Portable fundus camera image.
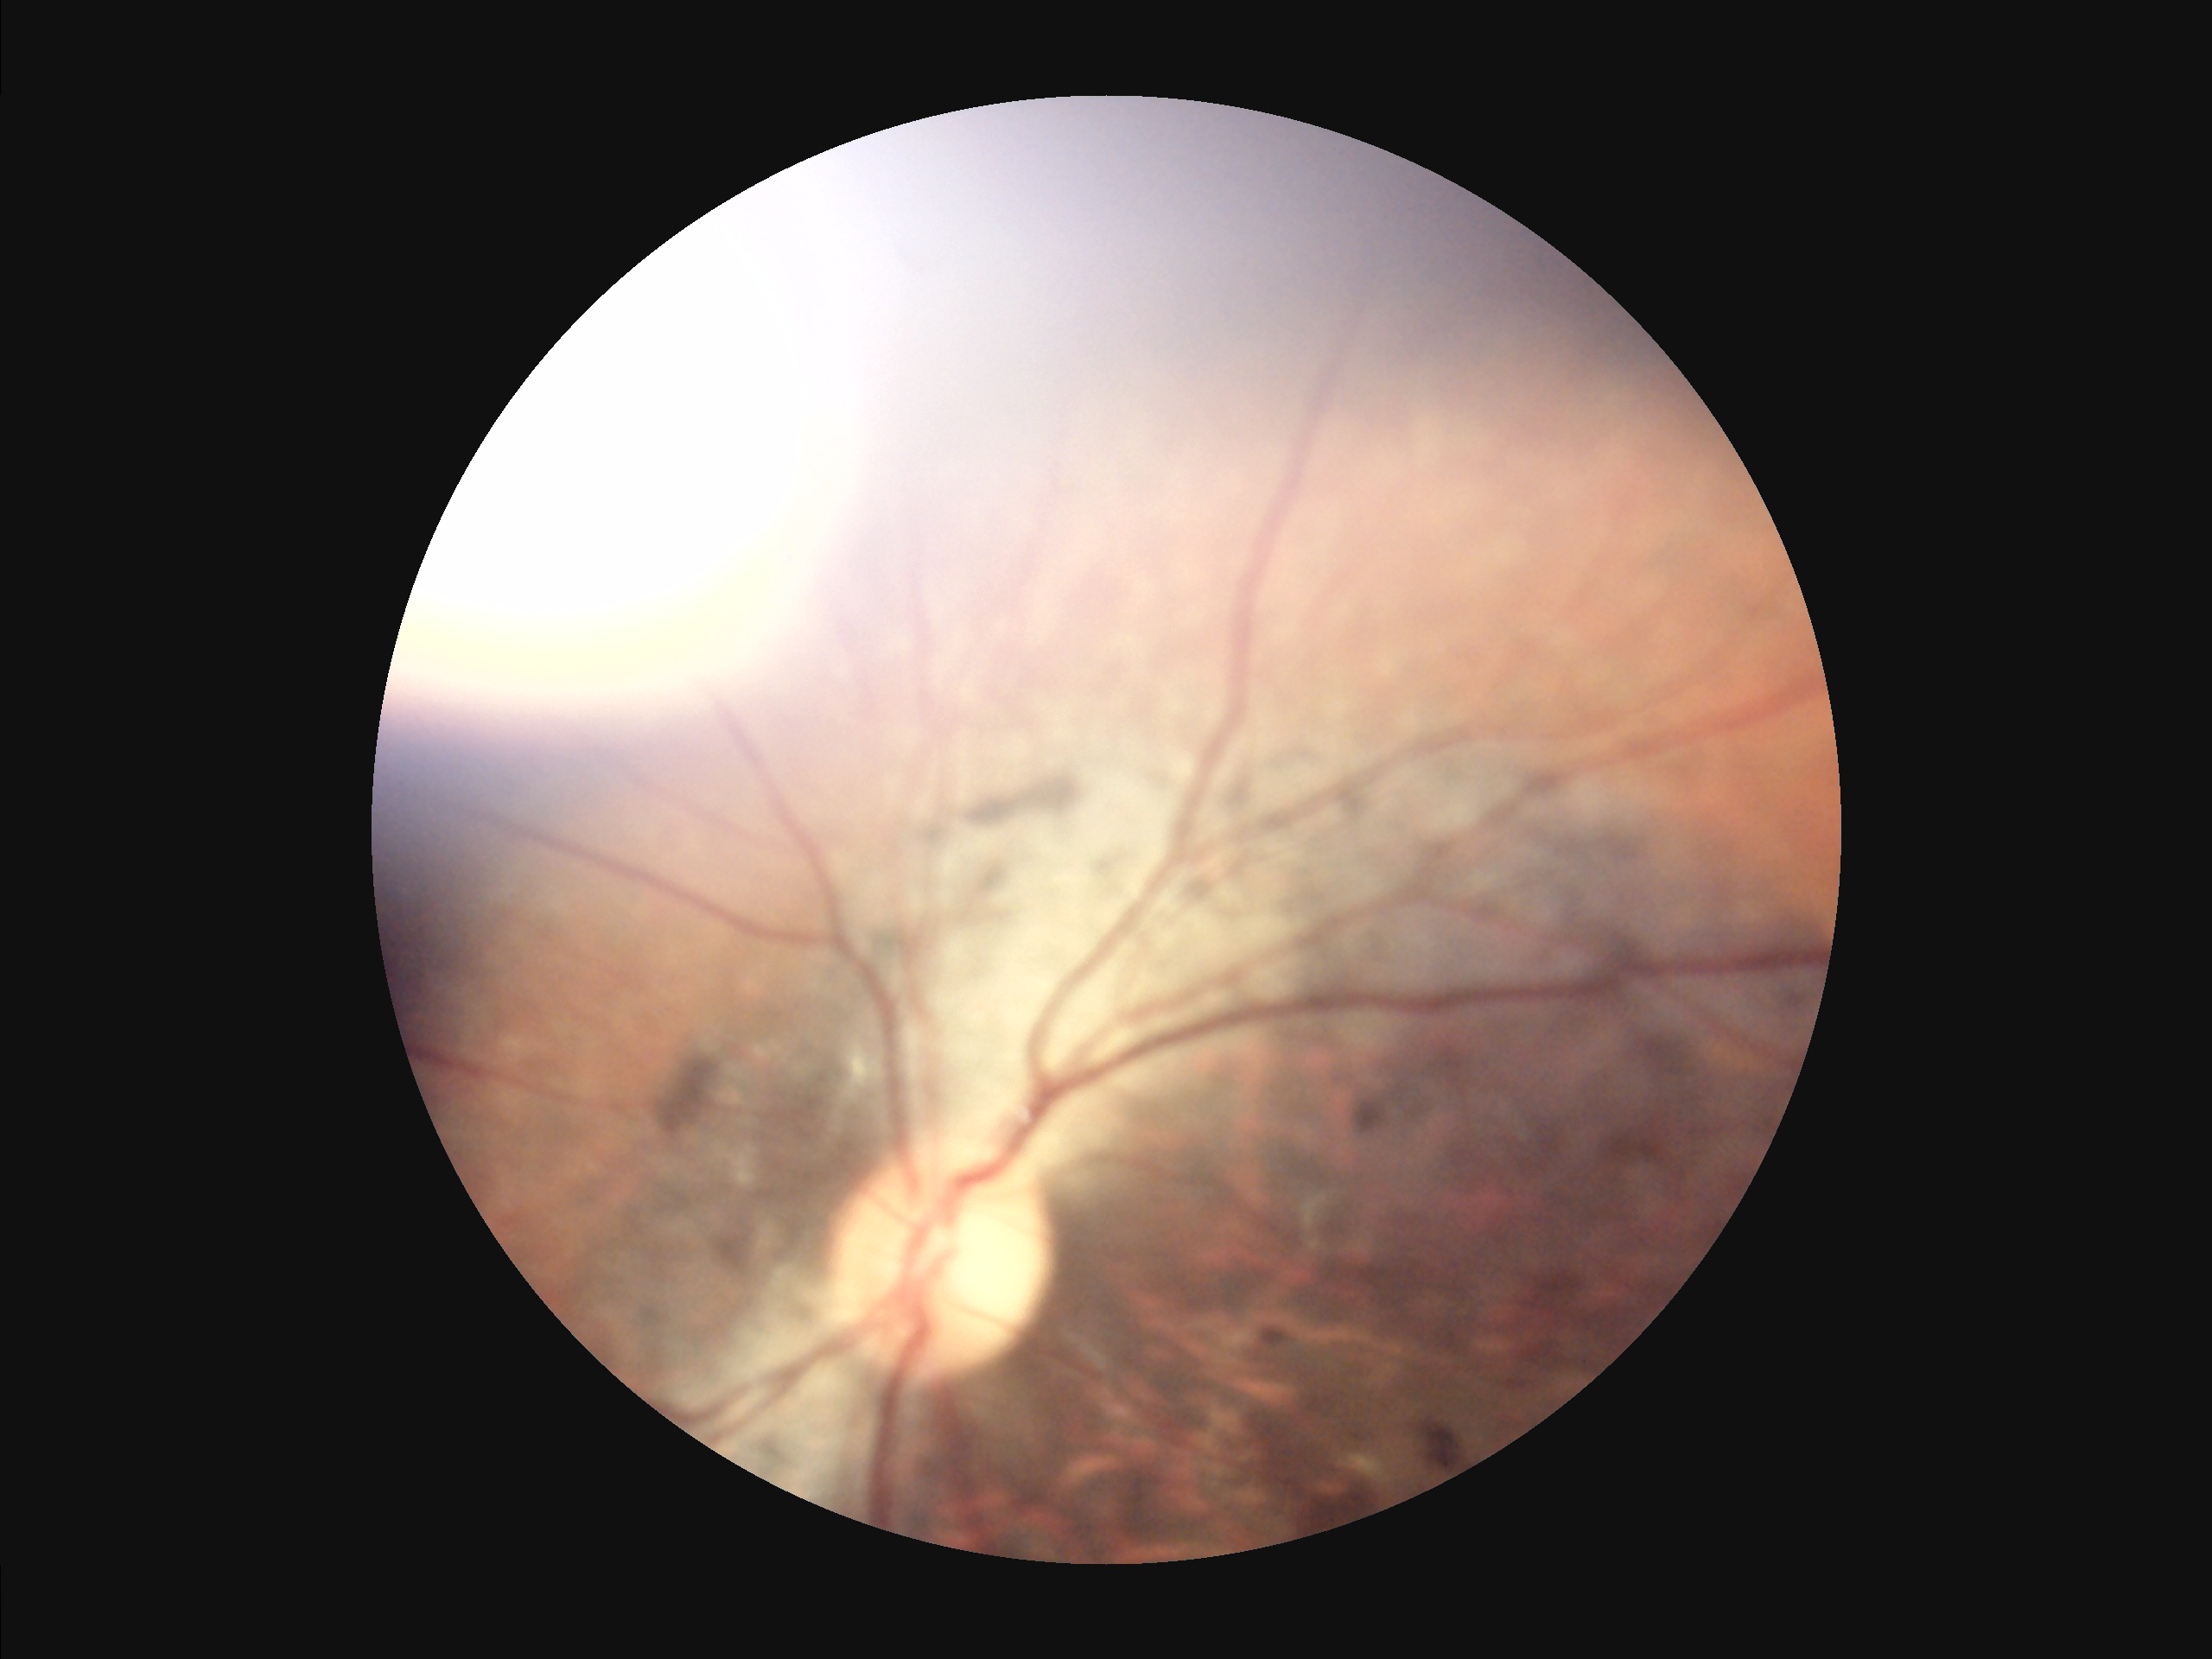 Noticeable blur in the optic disc, vessels, or background.
Narrow intensity range; structures are hard to distinguish.
Illumination is uneven.
Image quality is inadequate for diagnostic use.